45° field of view. 2352 x 1568 pixels.
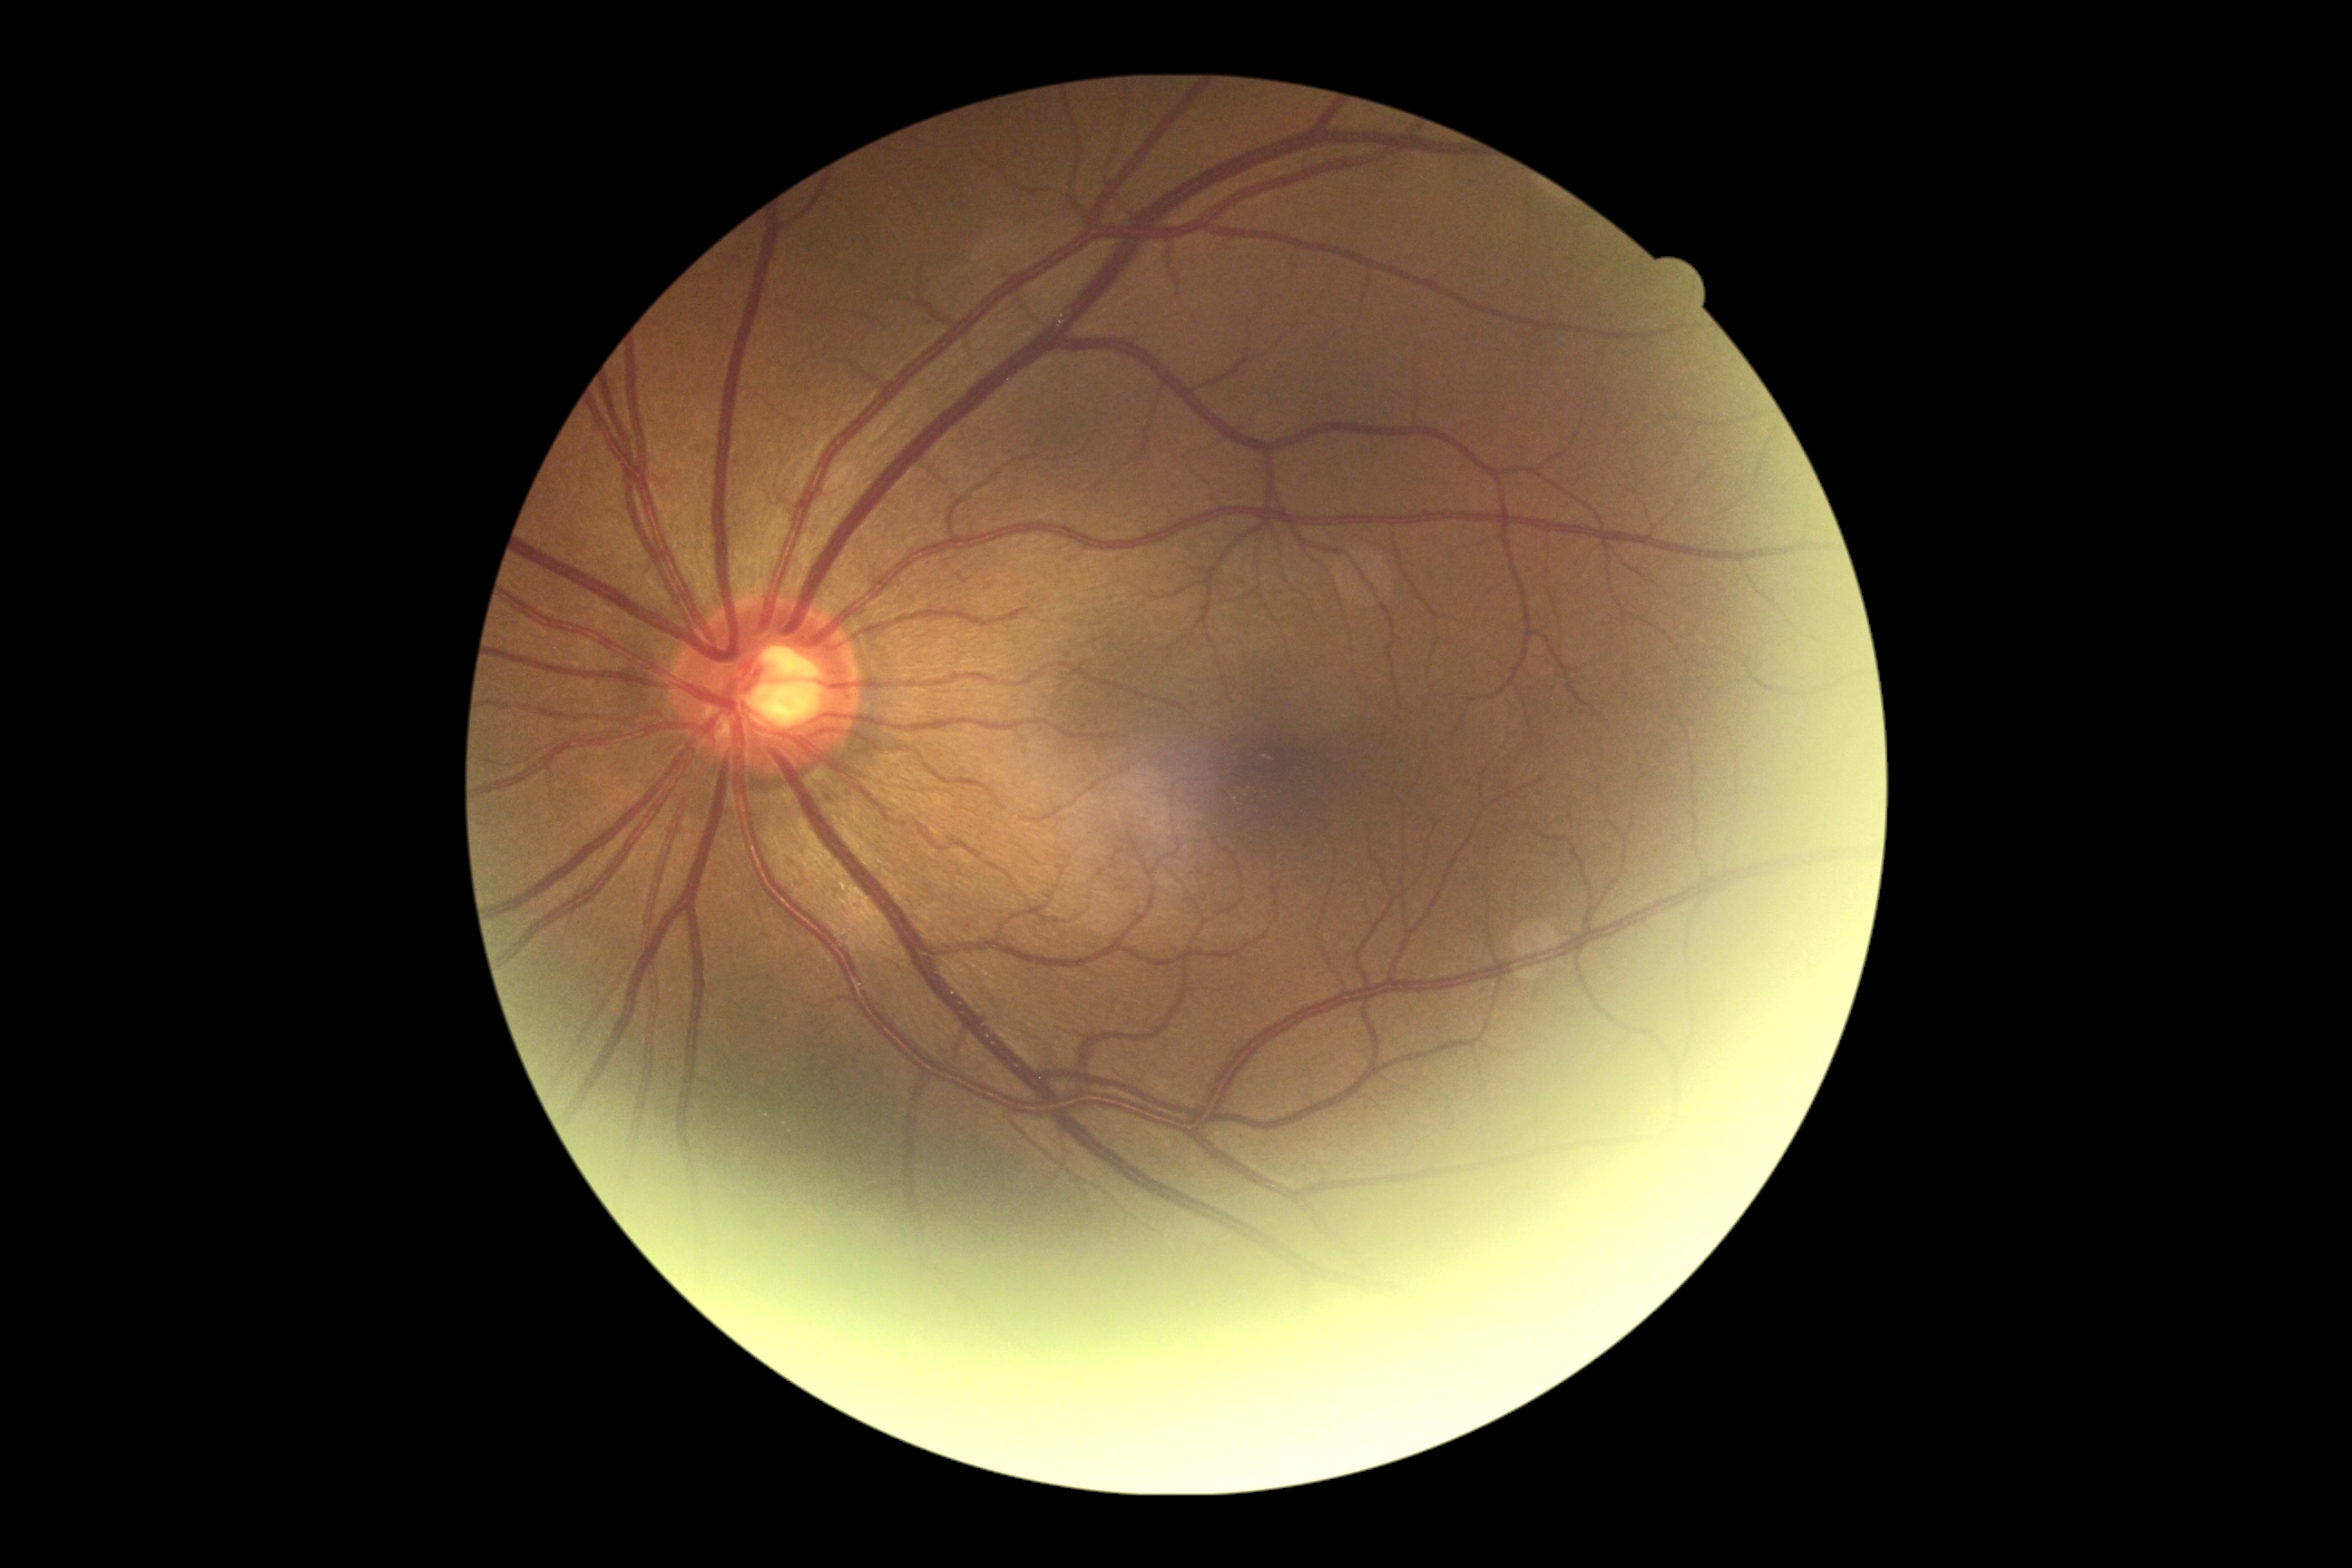 Diabetic retinopathy (DR) is 0/4 — no visible signs of diabetic retinopathy.